Wide-field fundus photograph of an infant:
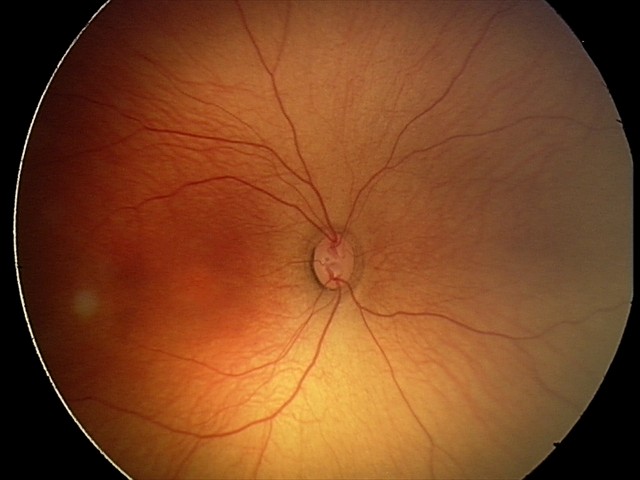

Physiological retinal appearance for postconceptual age.